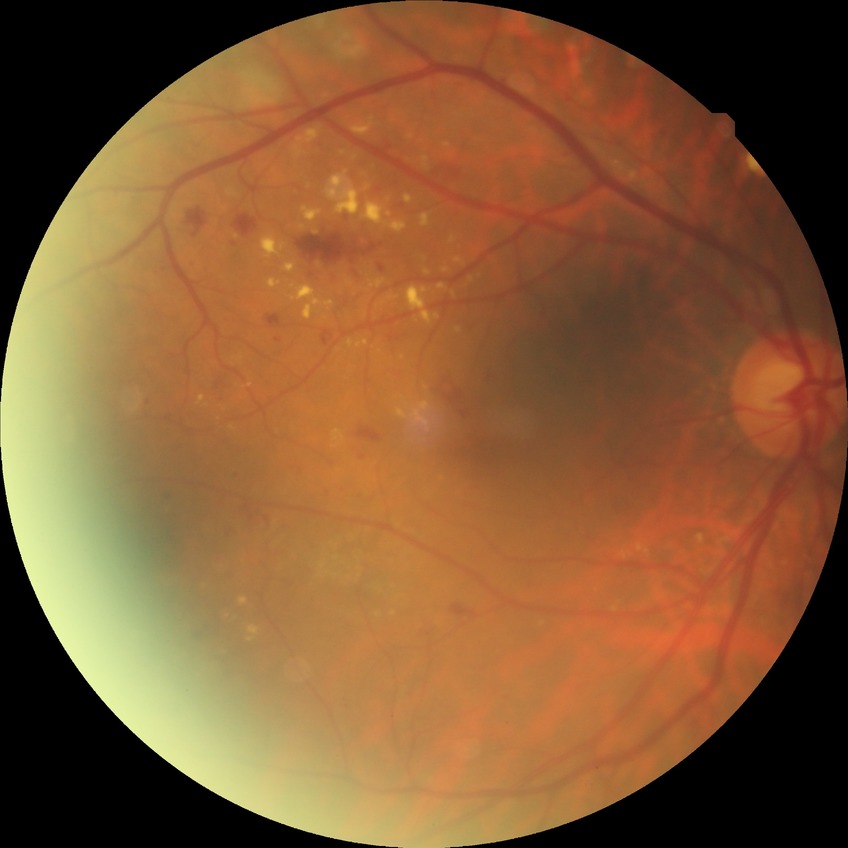
Modified Davis classification is pre-proliferative diabetic retinopathy.